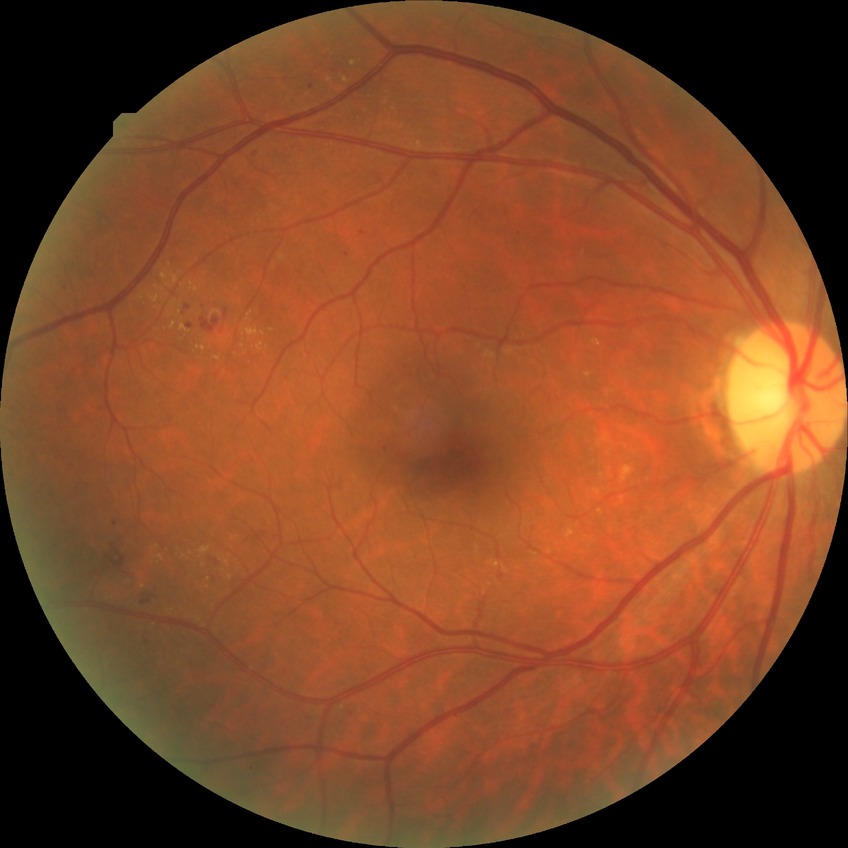 {
  "davis_grade": "SDR (simple diabetic retinopathy)"
}